Graded on the modified Davis scale · 45-degree field of view — 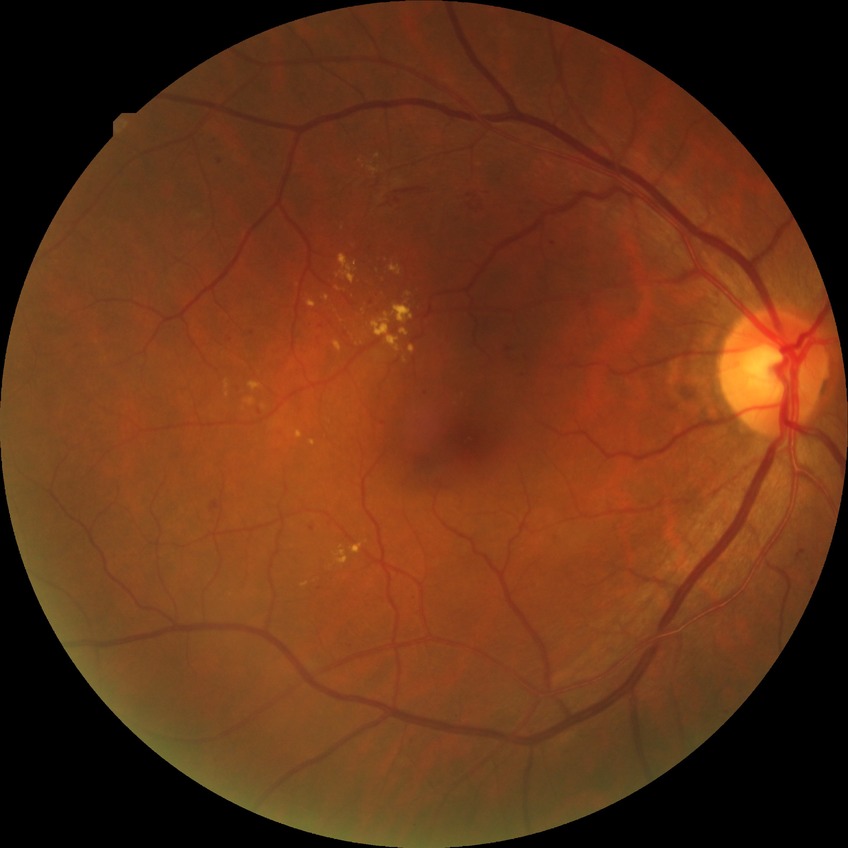
Diabetic retinopathy stage is simple diabetic retinopathy.